45 degree fundus photograph.
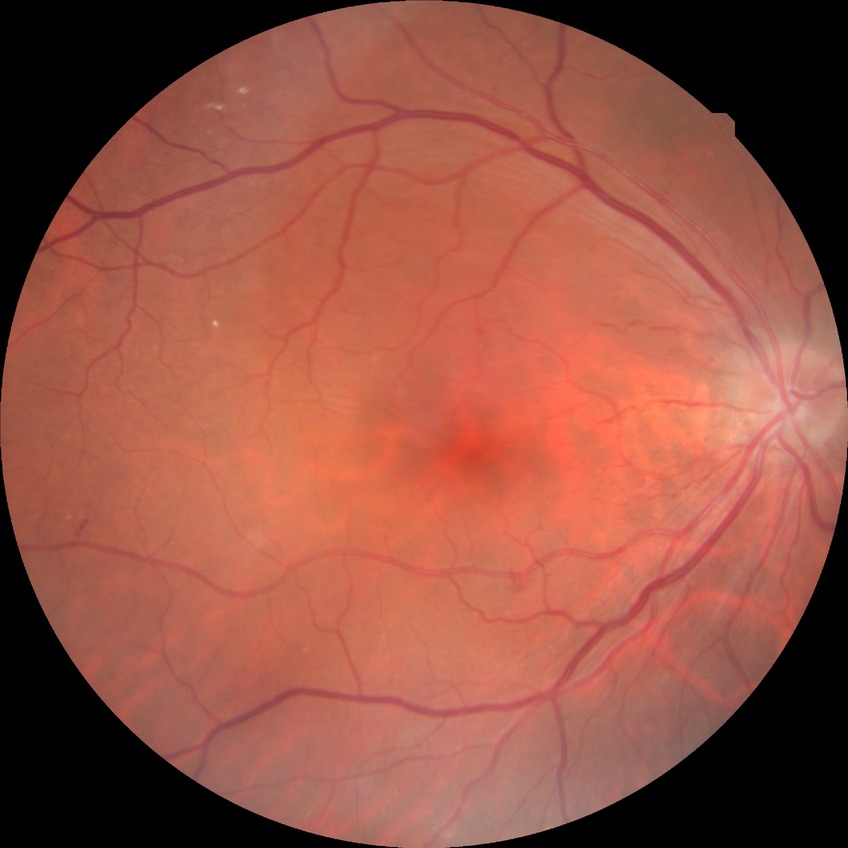 Diabetic retinopathy severity: simple diabetic retinopathy. Disease class: non-proliferative diabetic retinopathy.